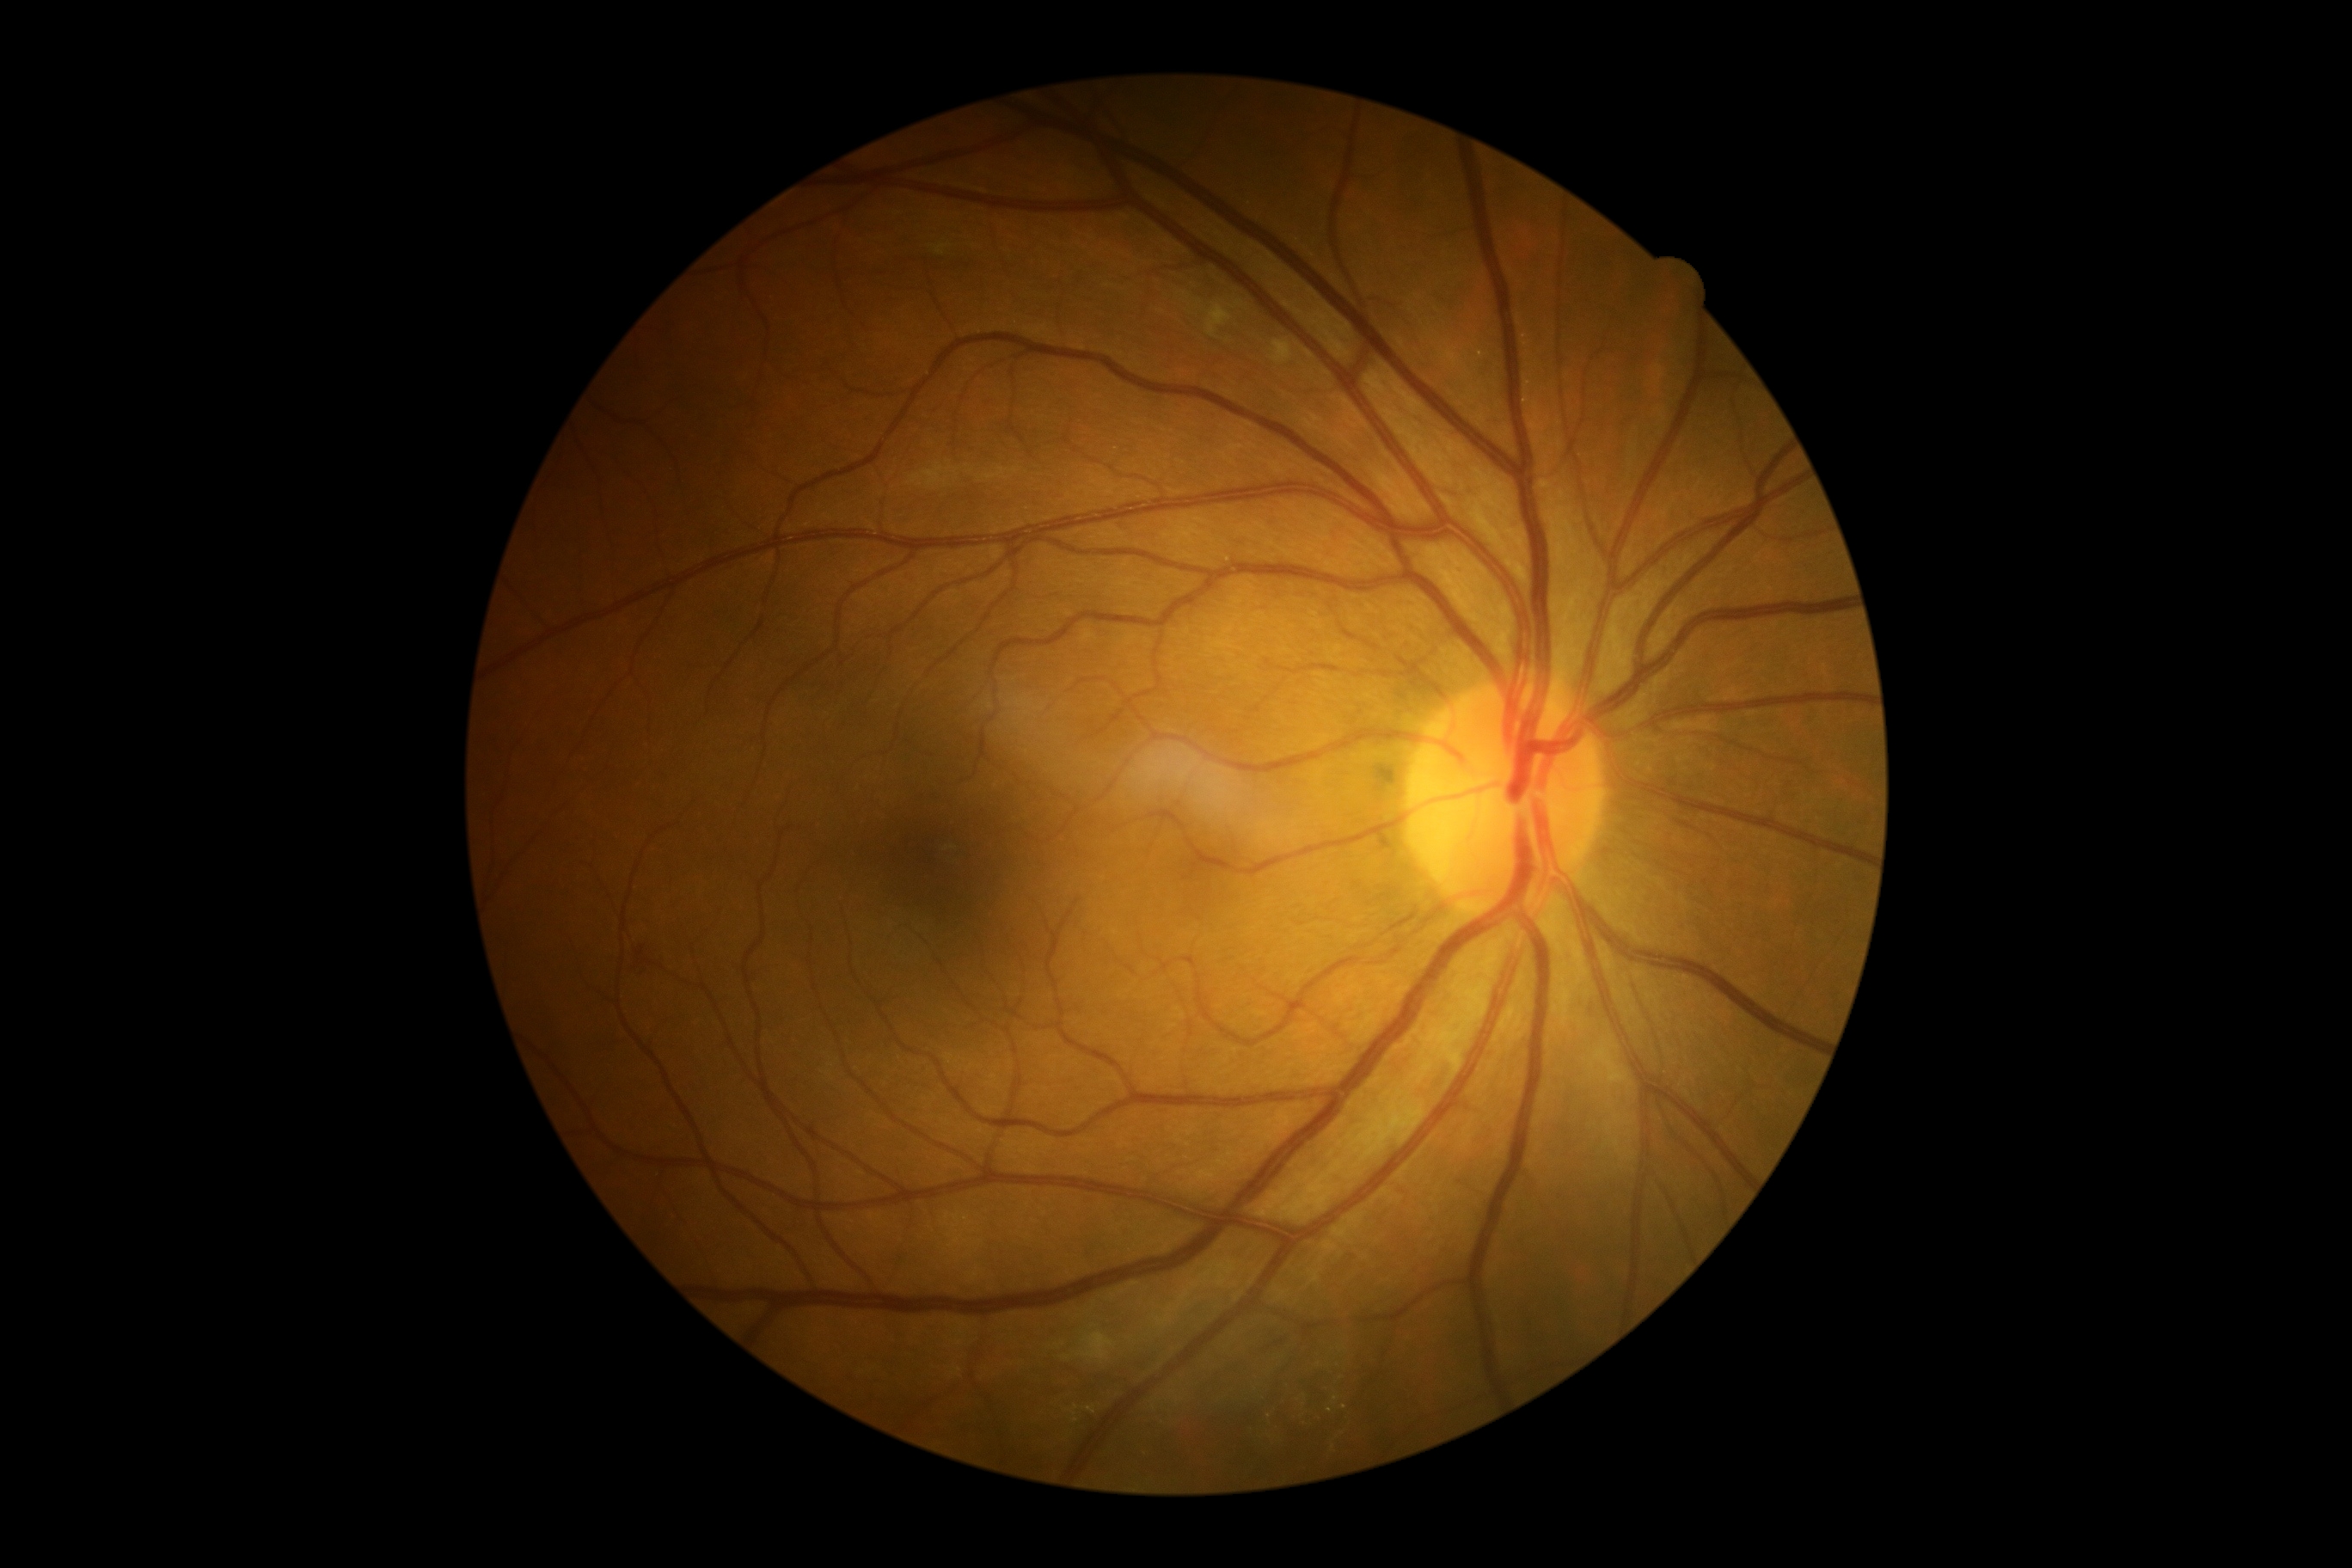

Findings:
* DR severity — grade 2 — more than just microaneurysms but less than severe NPDR